Image size 640x480 · acquired on the Clarity RetCam 3 · infant wide-field fundus photograph — 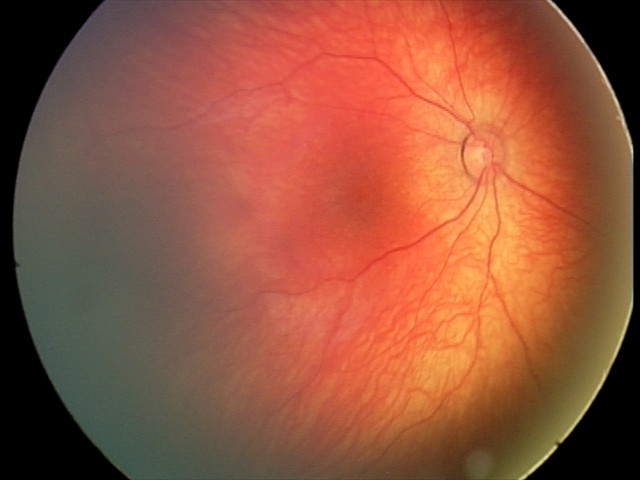

Impression: retinal hemorrhages.